45° FOV; 1932x1910px — 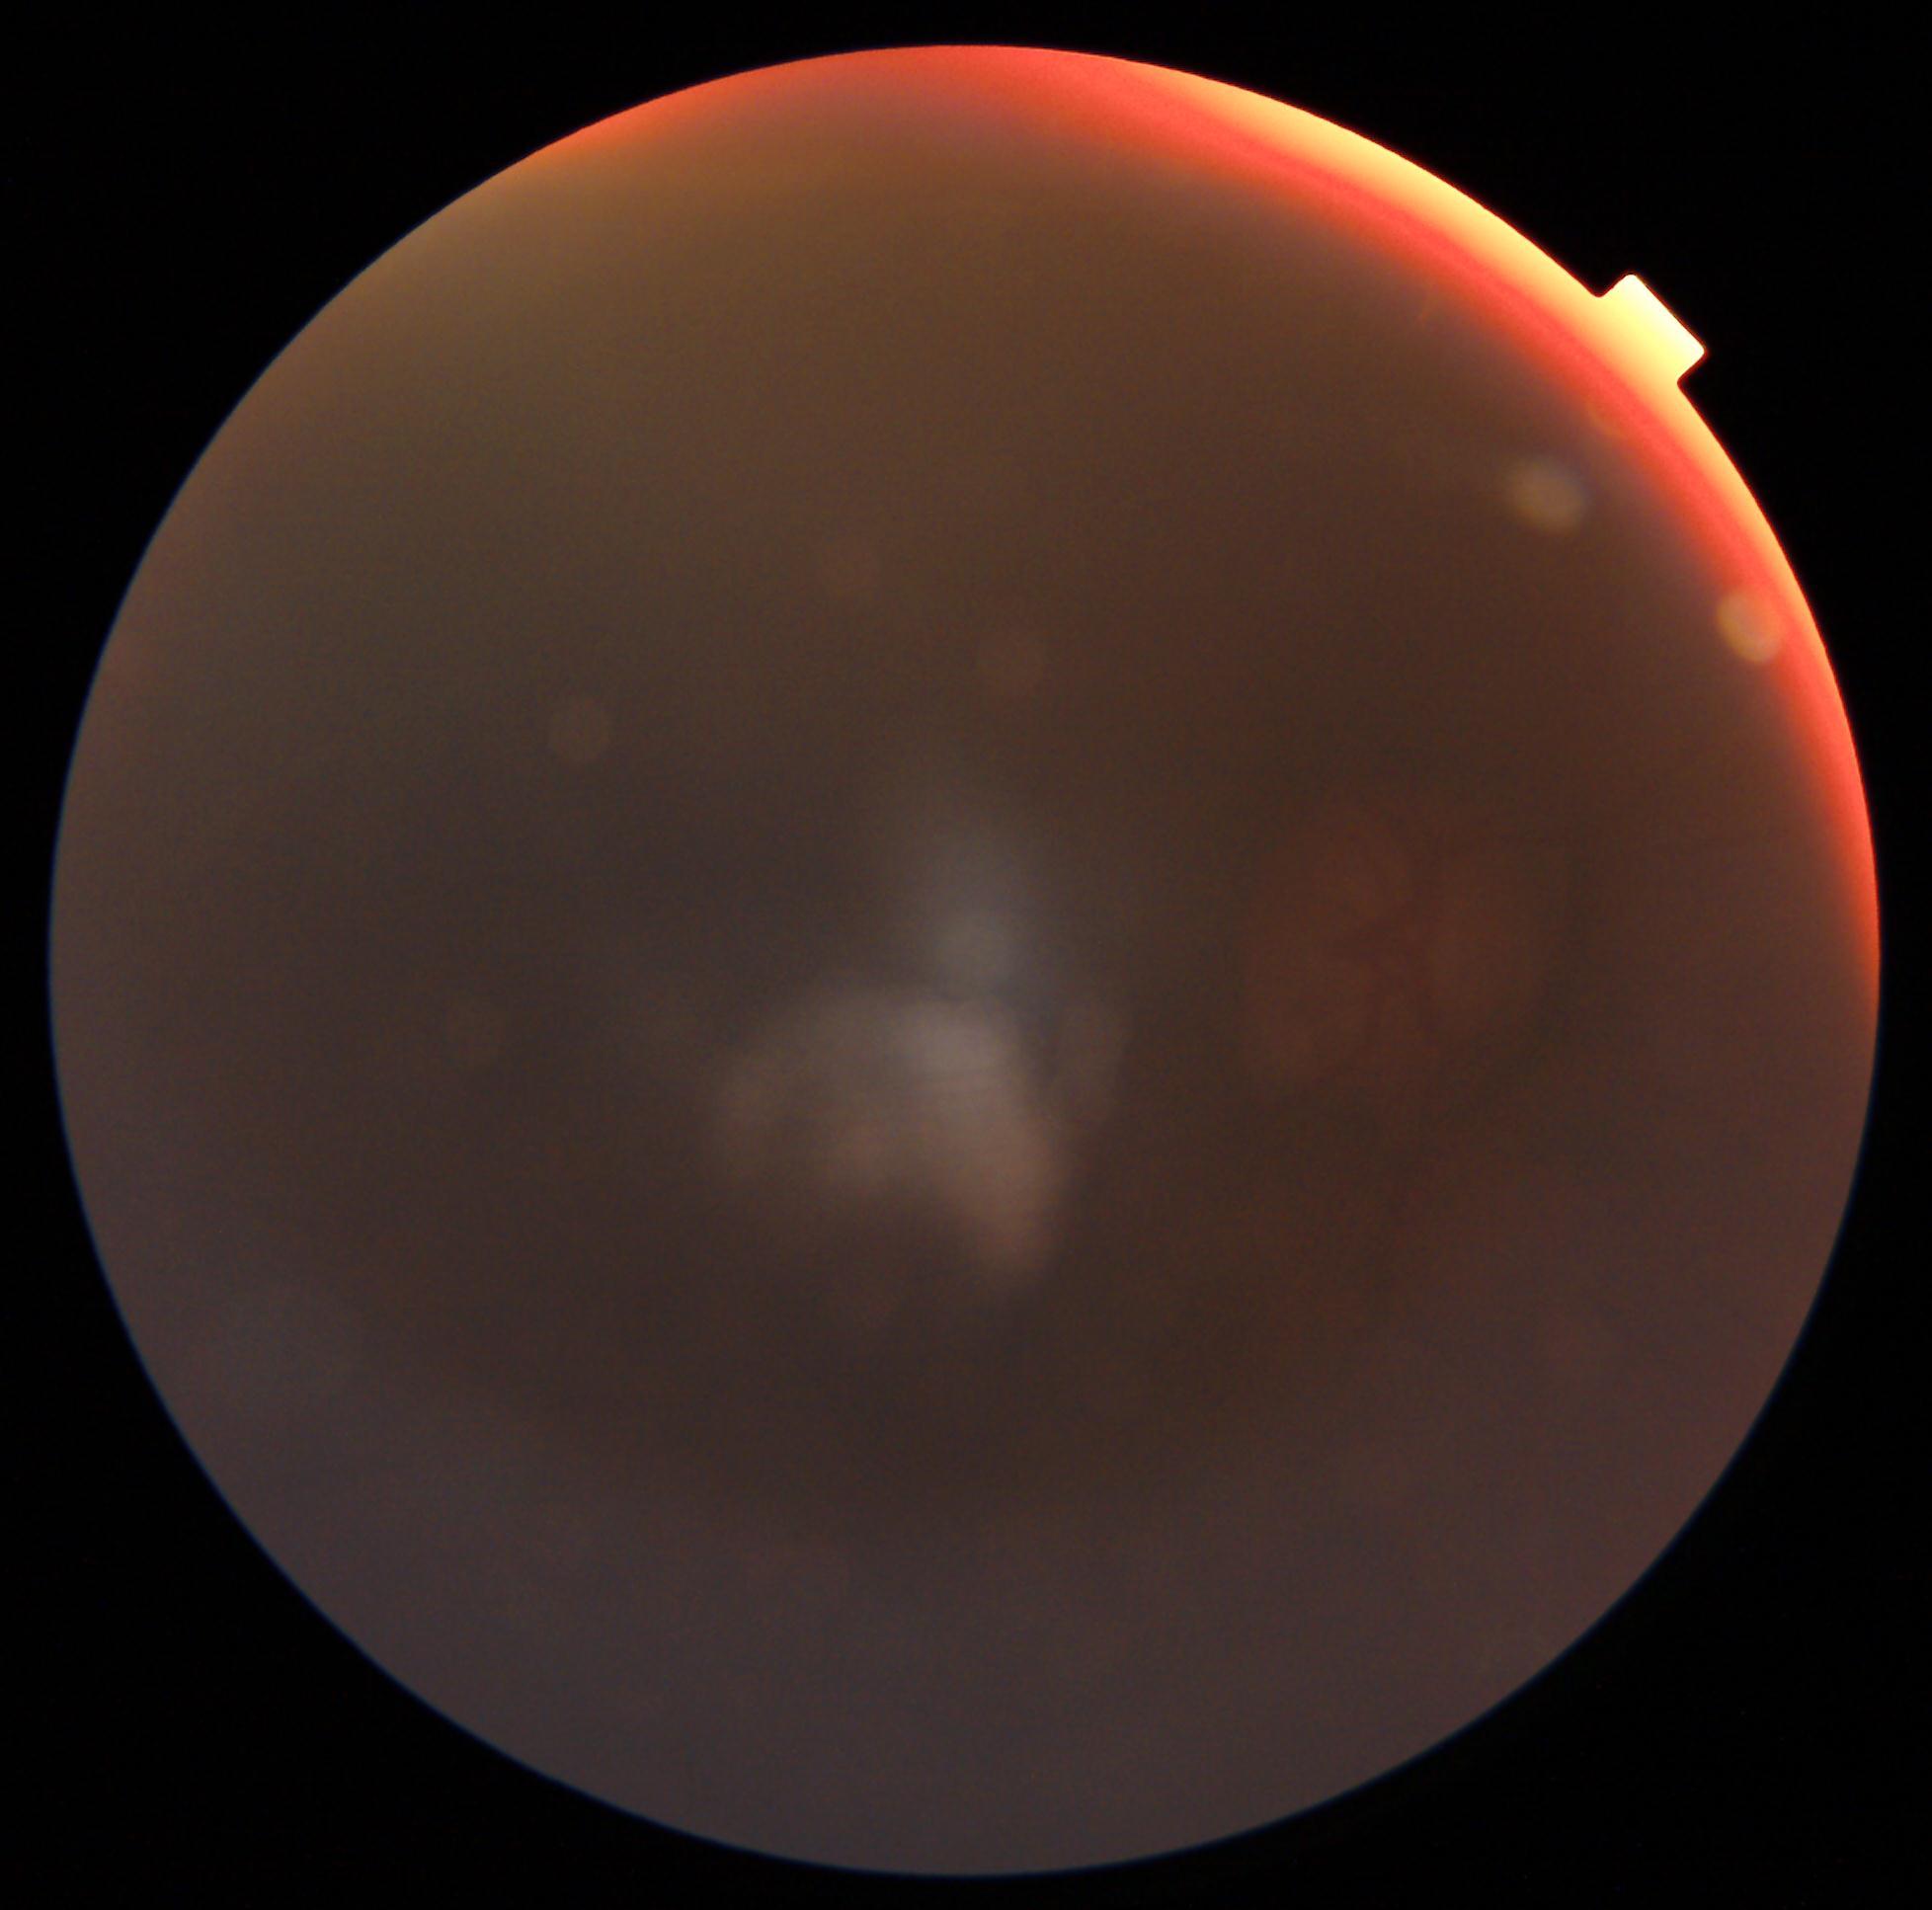
The image cannot be graded for diabetic retinopathy.
DR: ungradable.